2212 by 1659 pixels: 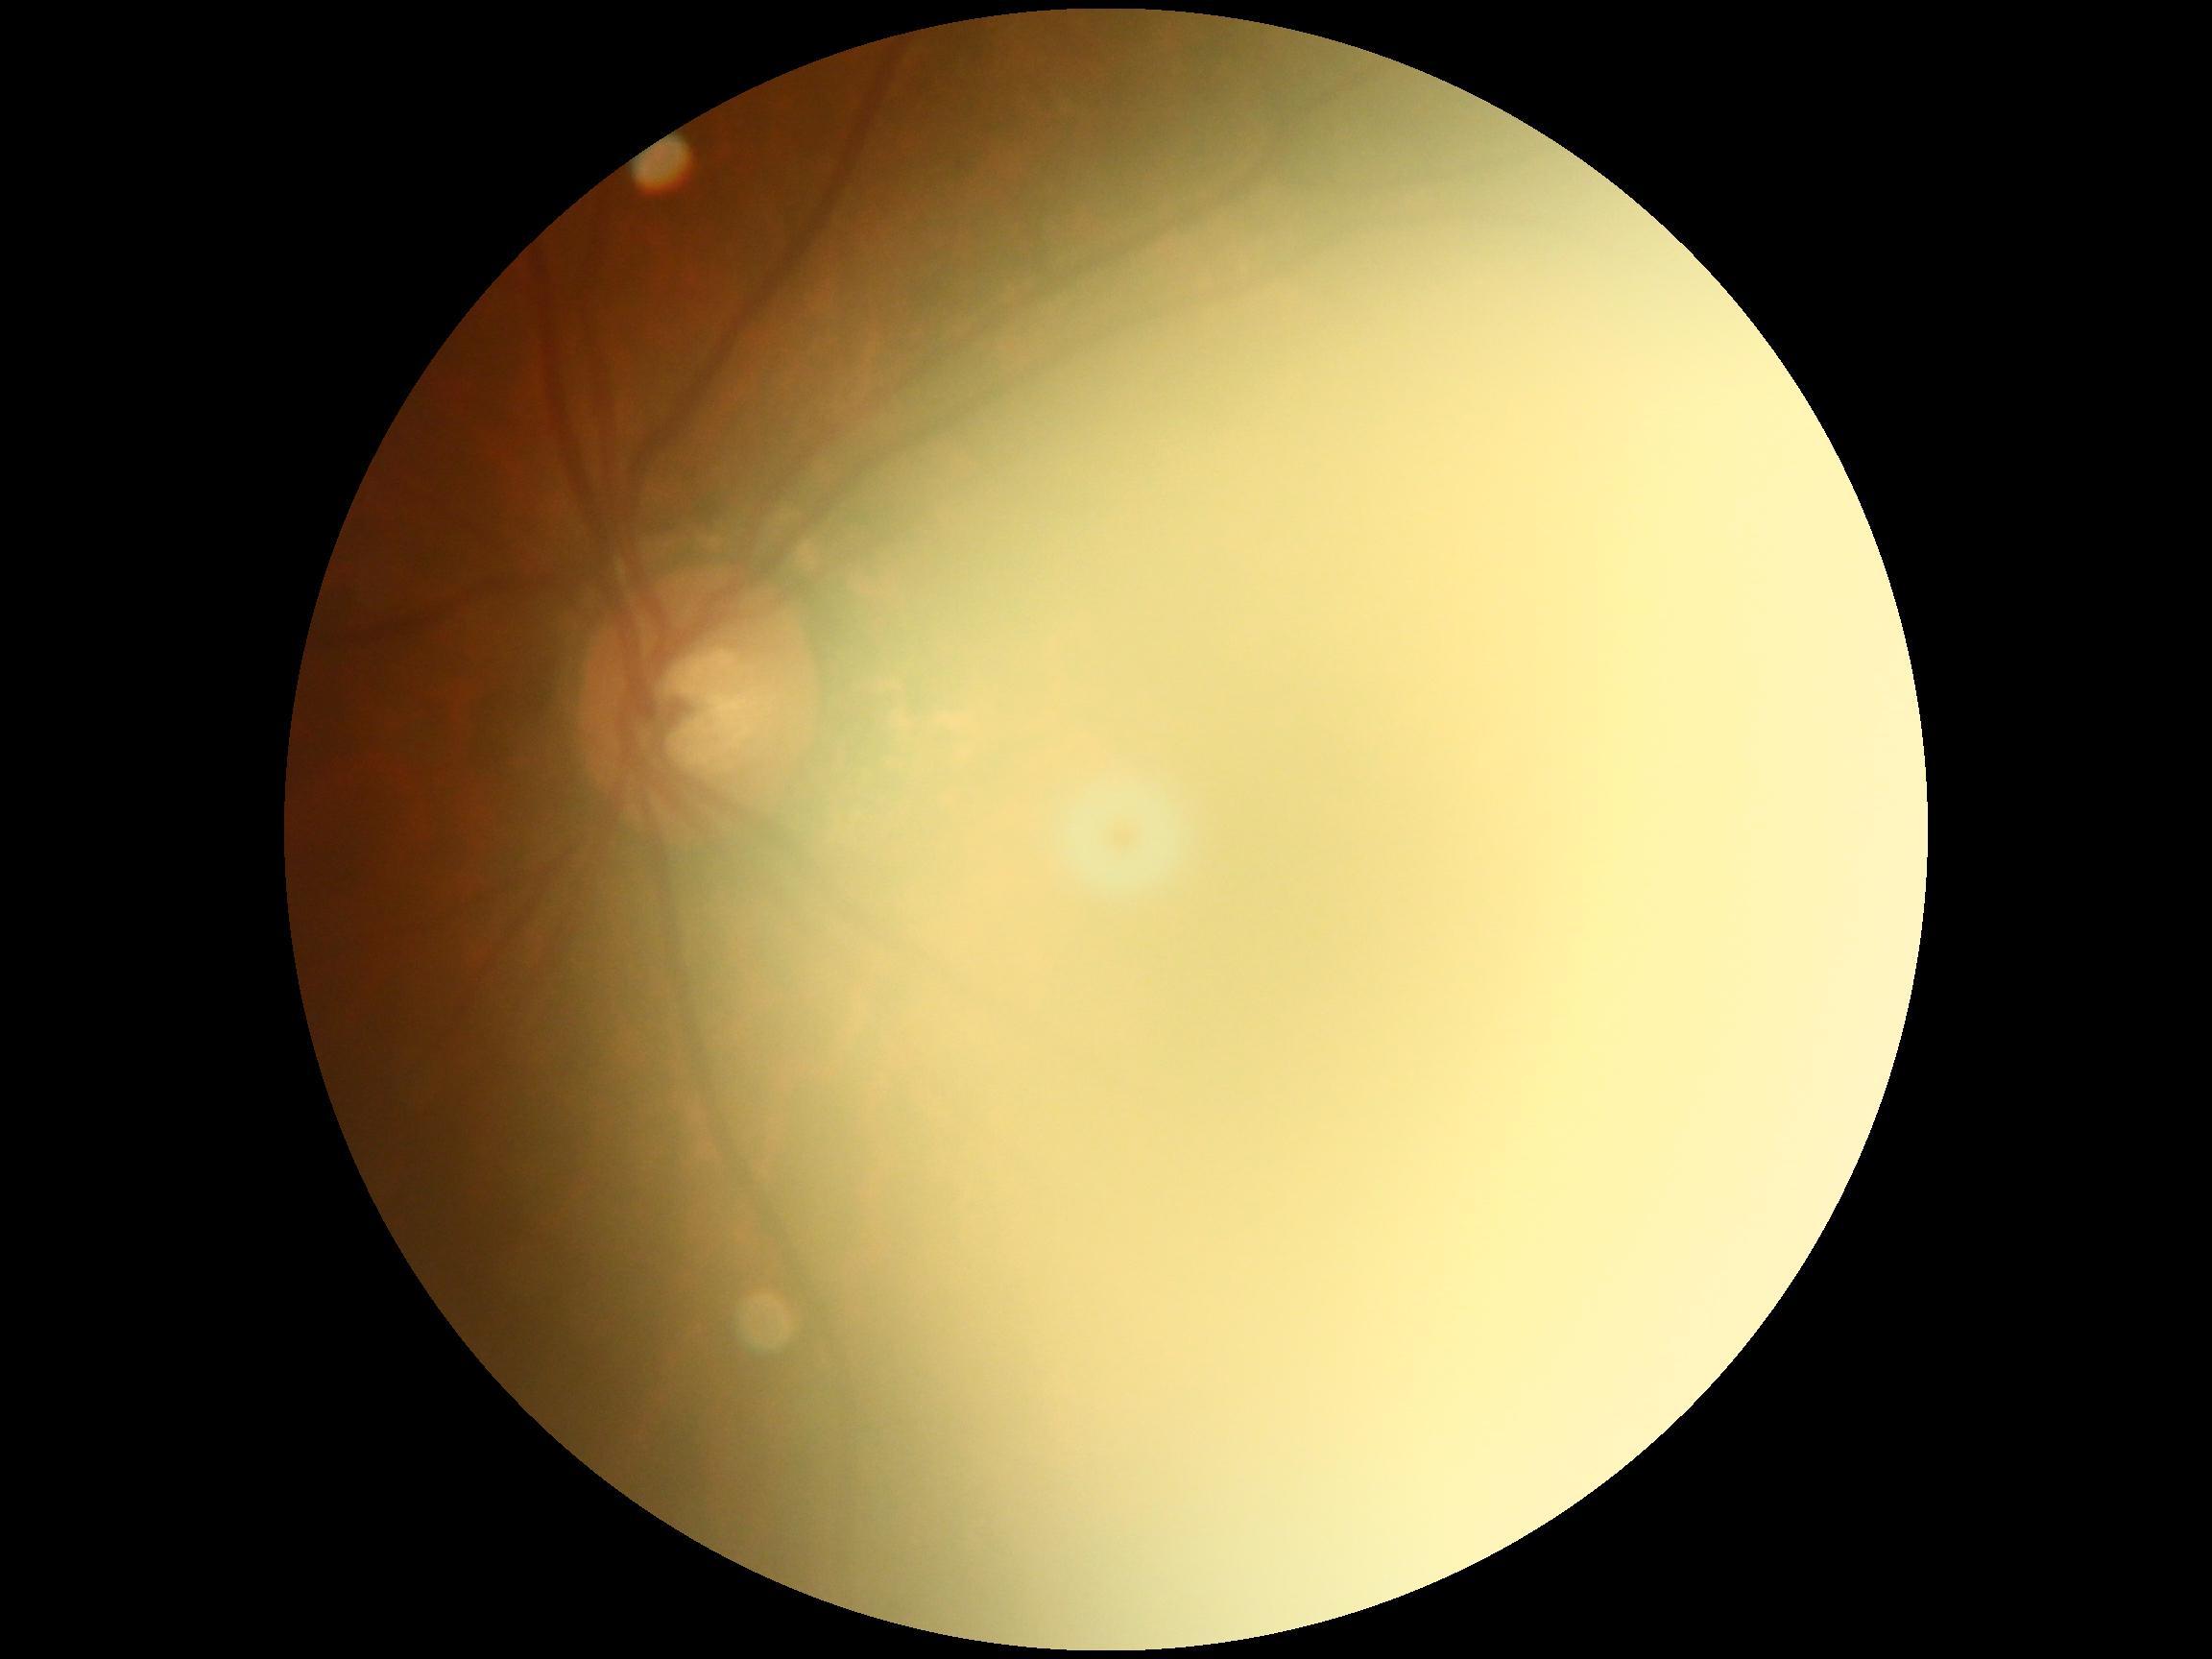 diabetic retinopathy (DR)@ungradable due to poor image quality.